FOV: 45 degrees. Color fundus image: 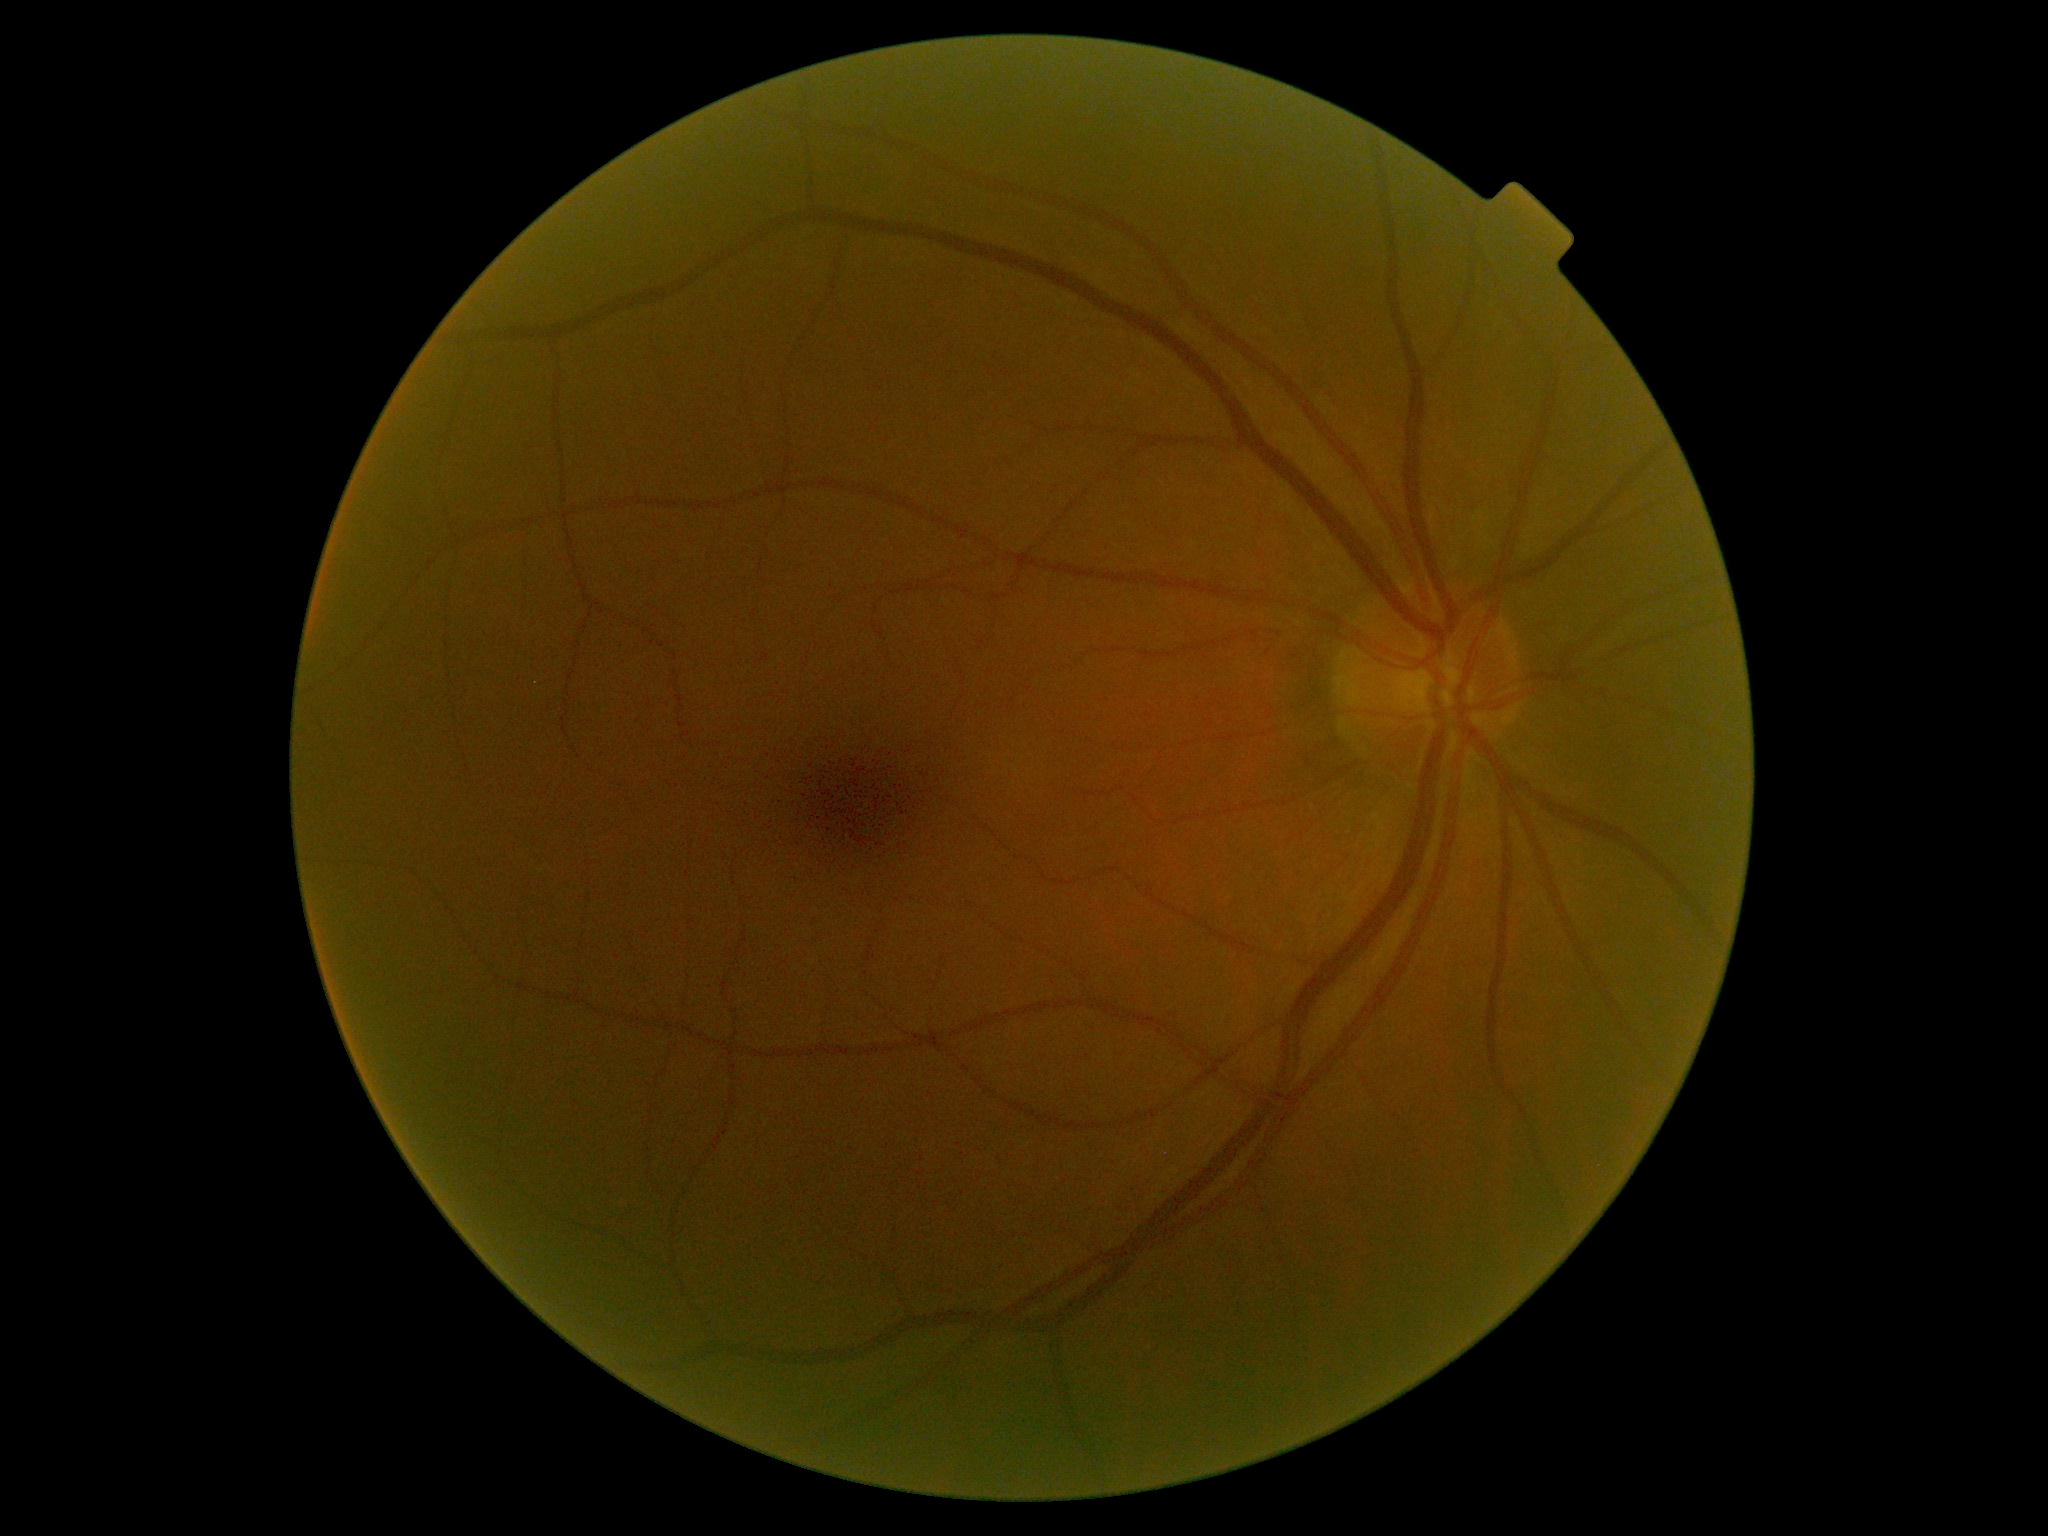 Annotations:
- retinopathy grade — 0 (no apparent retinopathy)